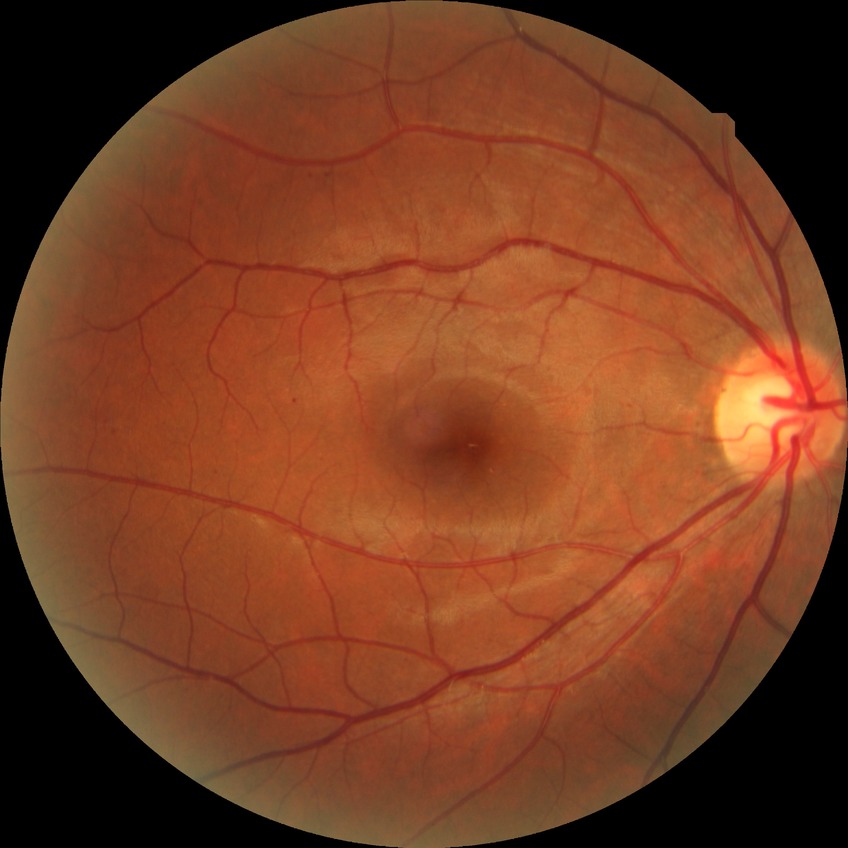 Diabetic retinopathy (DR) is SDR (simple diabetic retinopathy).